RetCam wide-field infant fundus image; acquired on the Clarity RetCam 3.
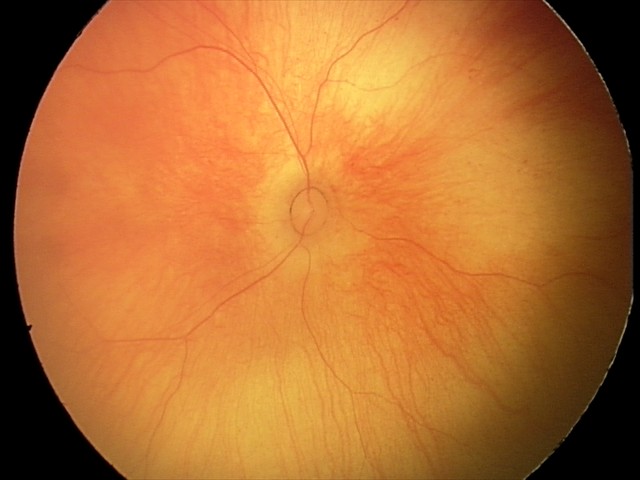
Screening examination with no abnormal retinal findings.